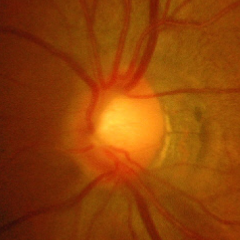 Q: Does this eye have glaucoma?
A: Yes — severe glaucomatous damage.